Visual field mean deviation: -1.99 dB:
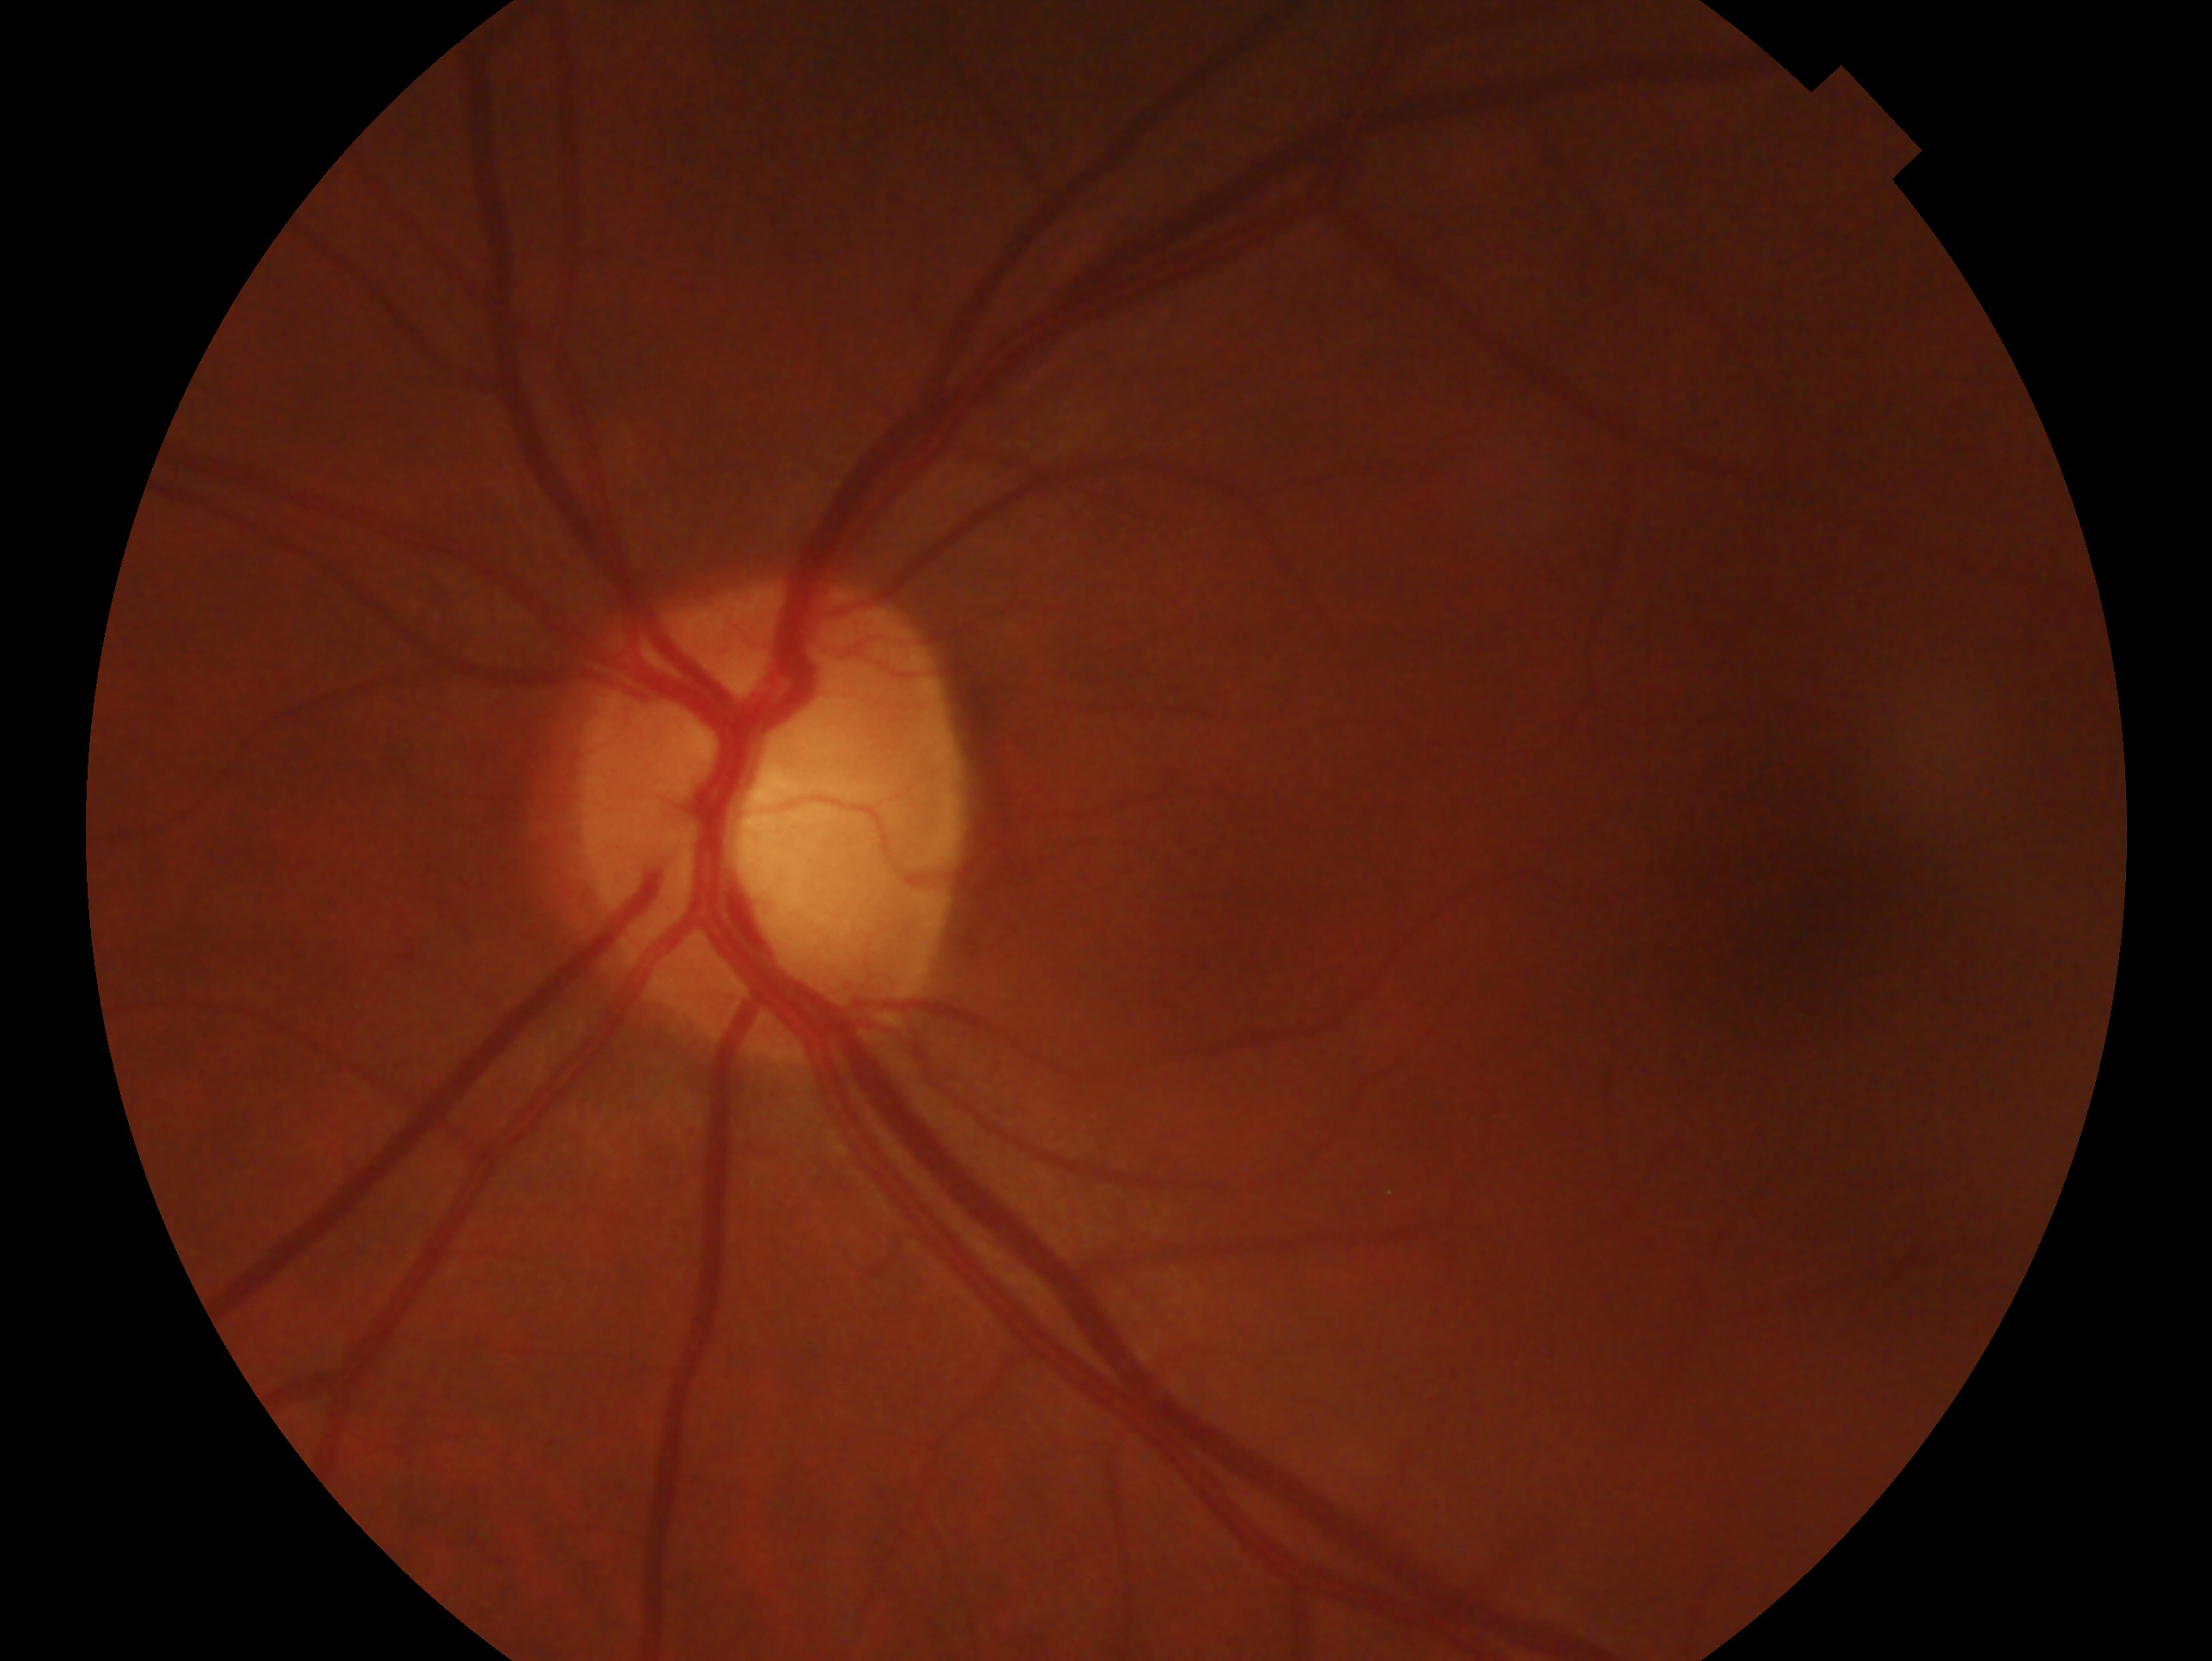
Imaged eye: left eye. Clinical classification — glaucoma cannot be excluded.